Color fundus photograph — 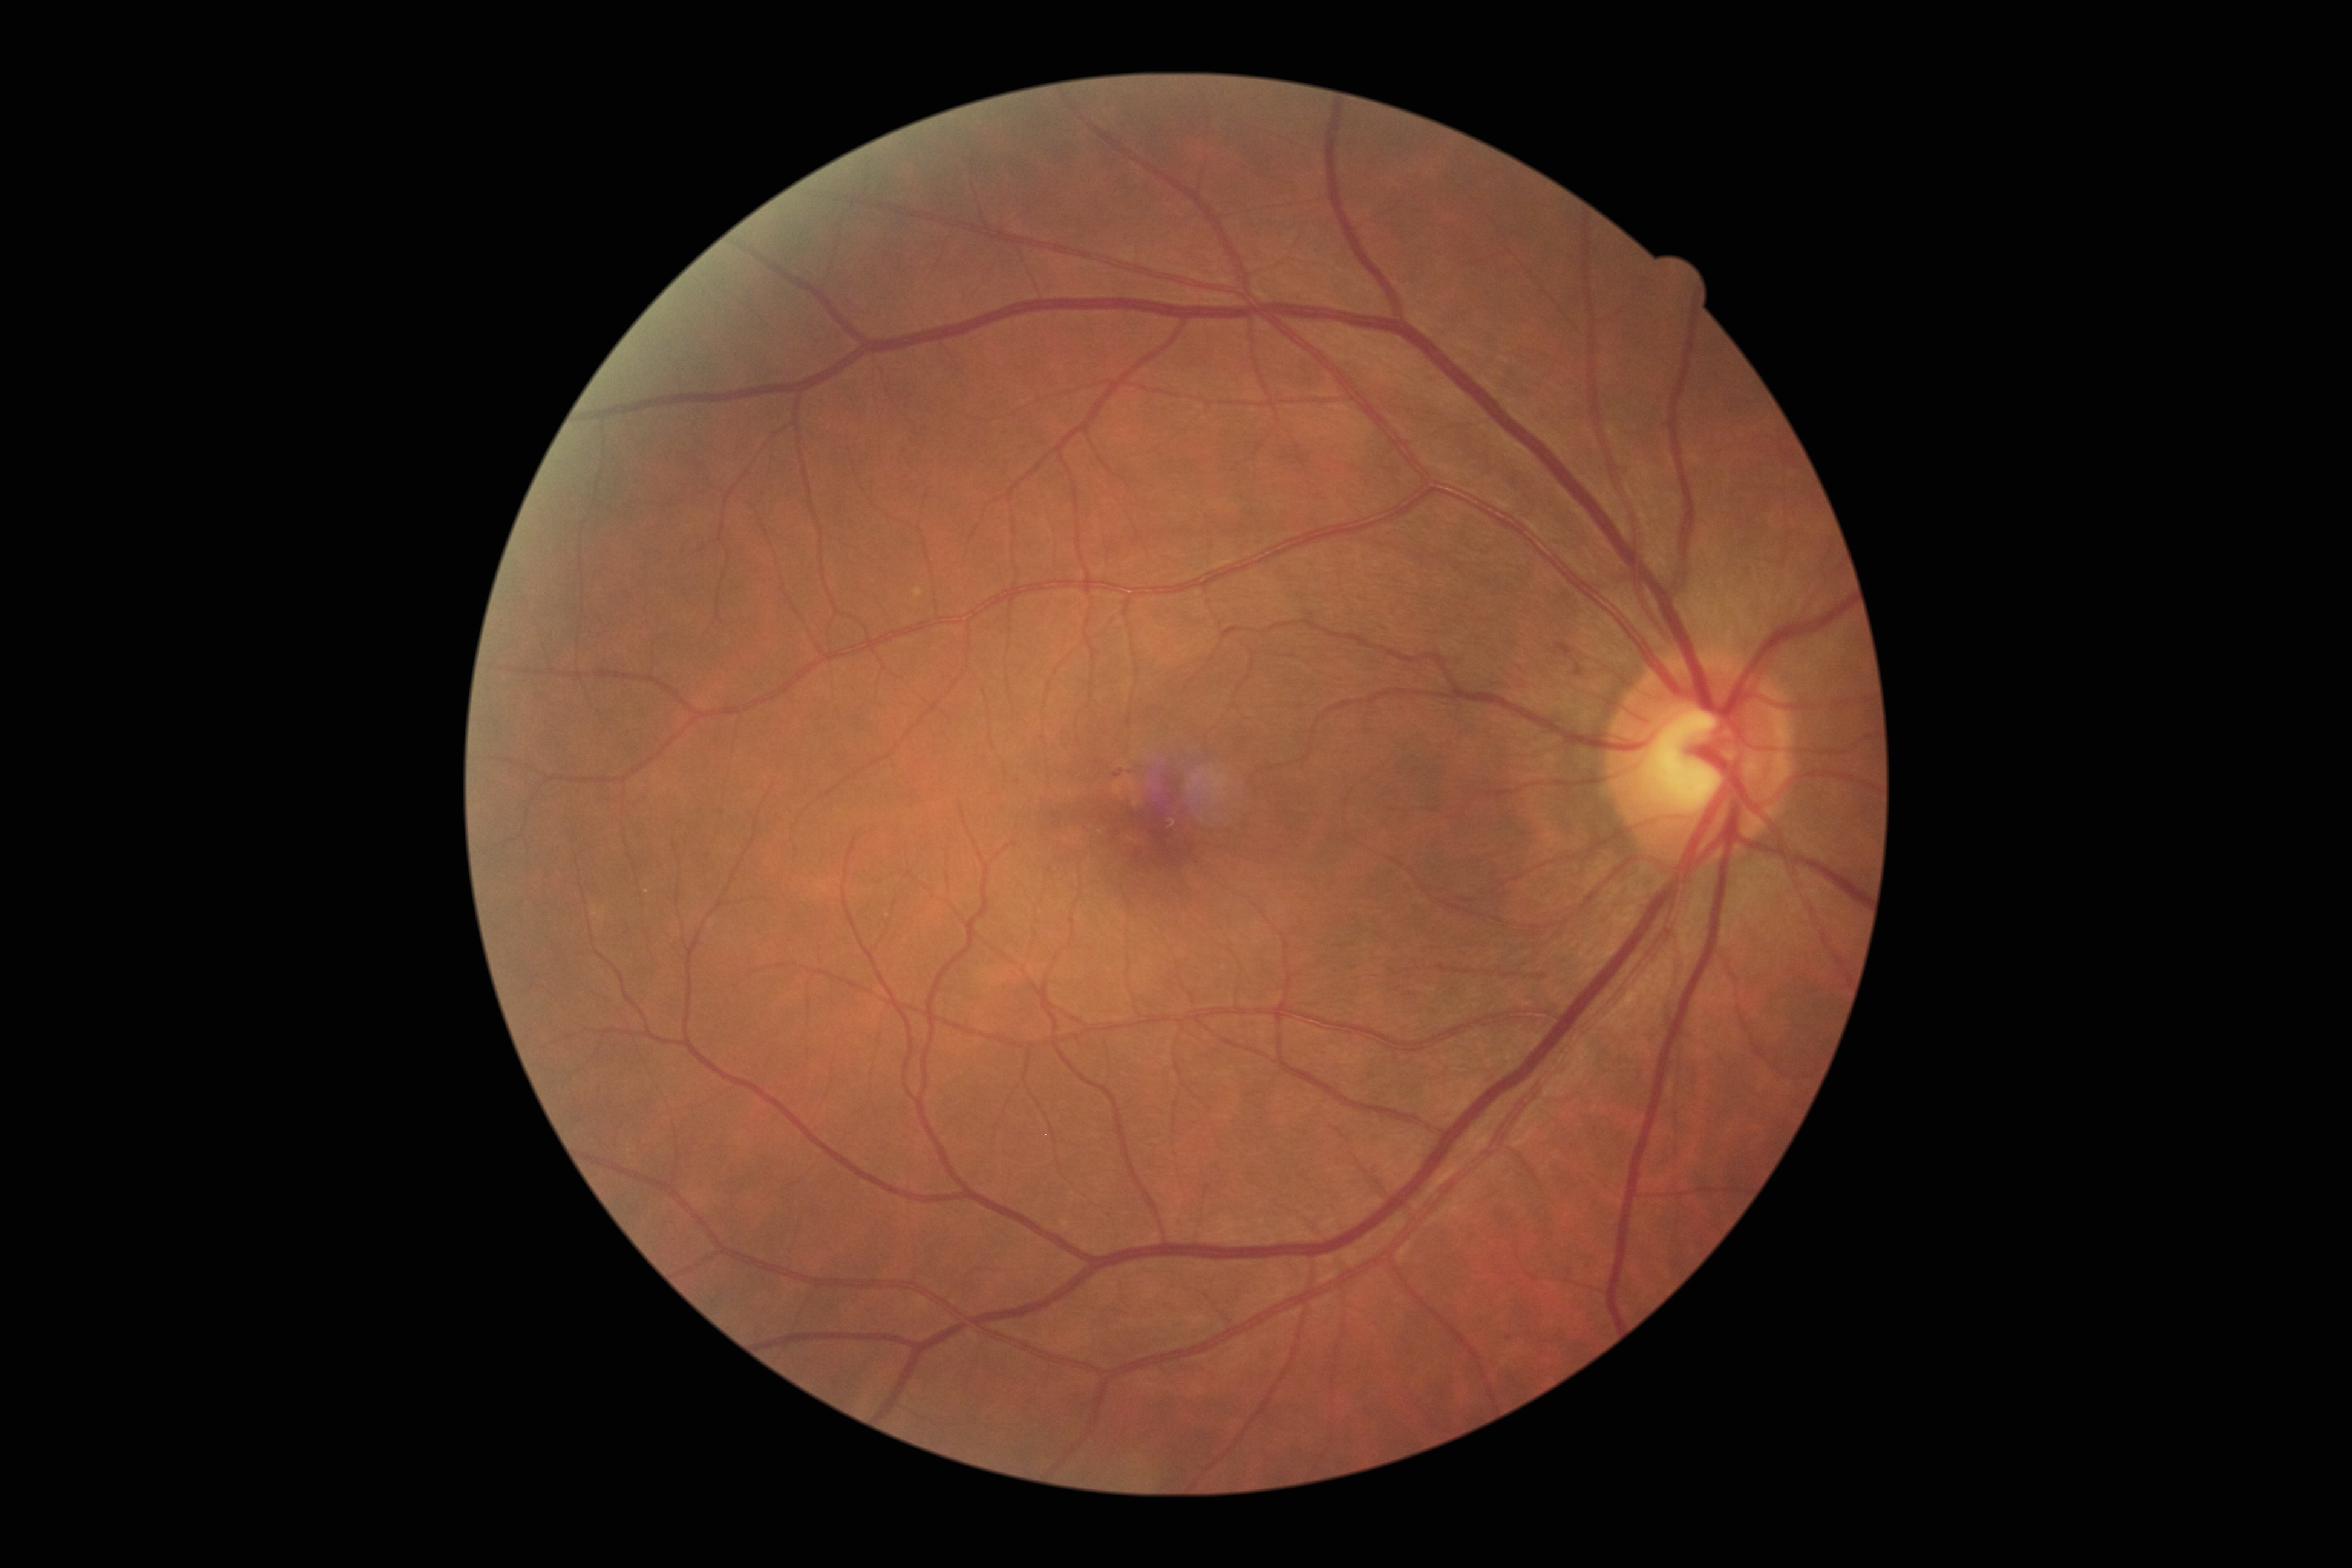 DR class: non-proliferative diabetic retinopathy. DR grade: 1 (mild NPDR).